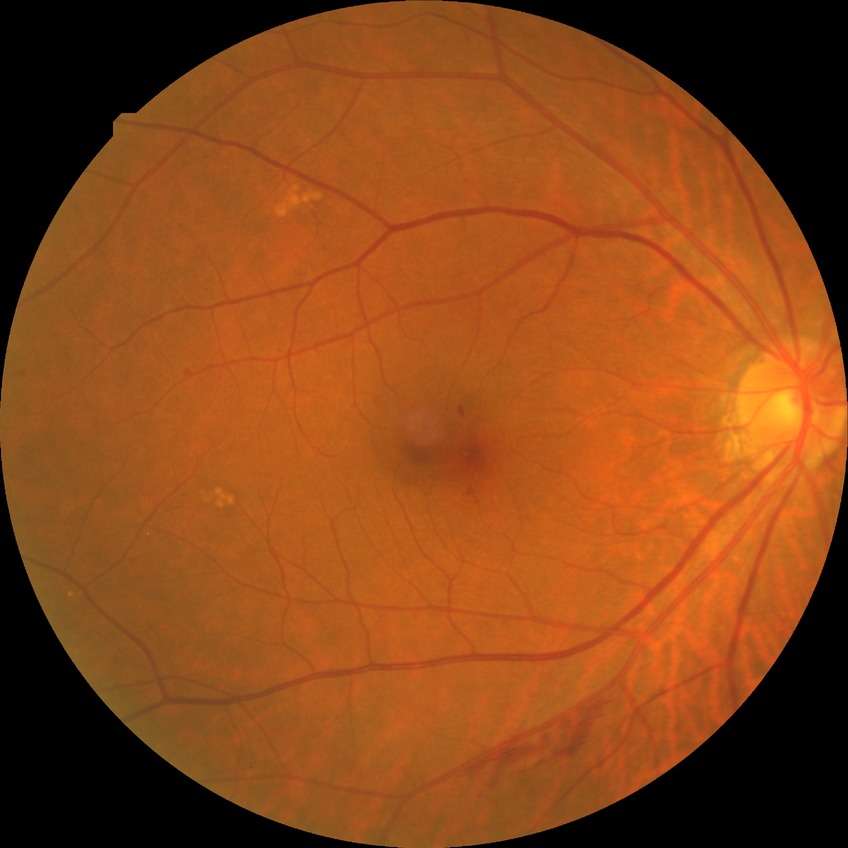
diabetic retinopathy (DR): simple diabetic retinopathy (SDR).